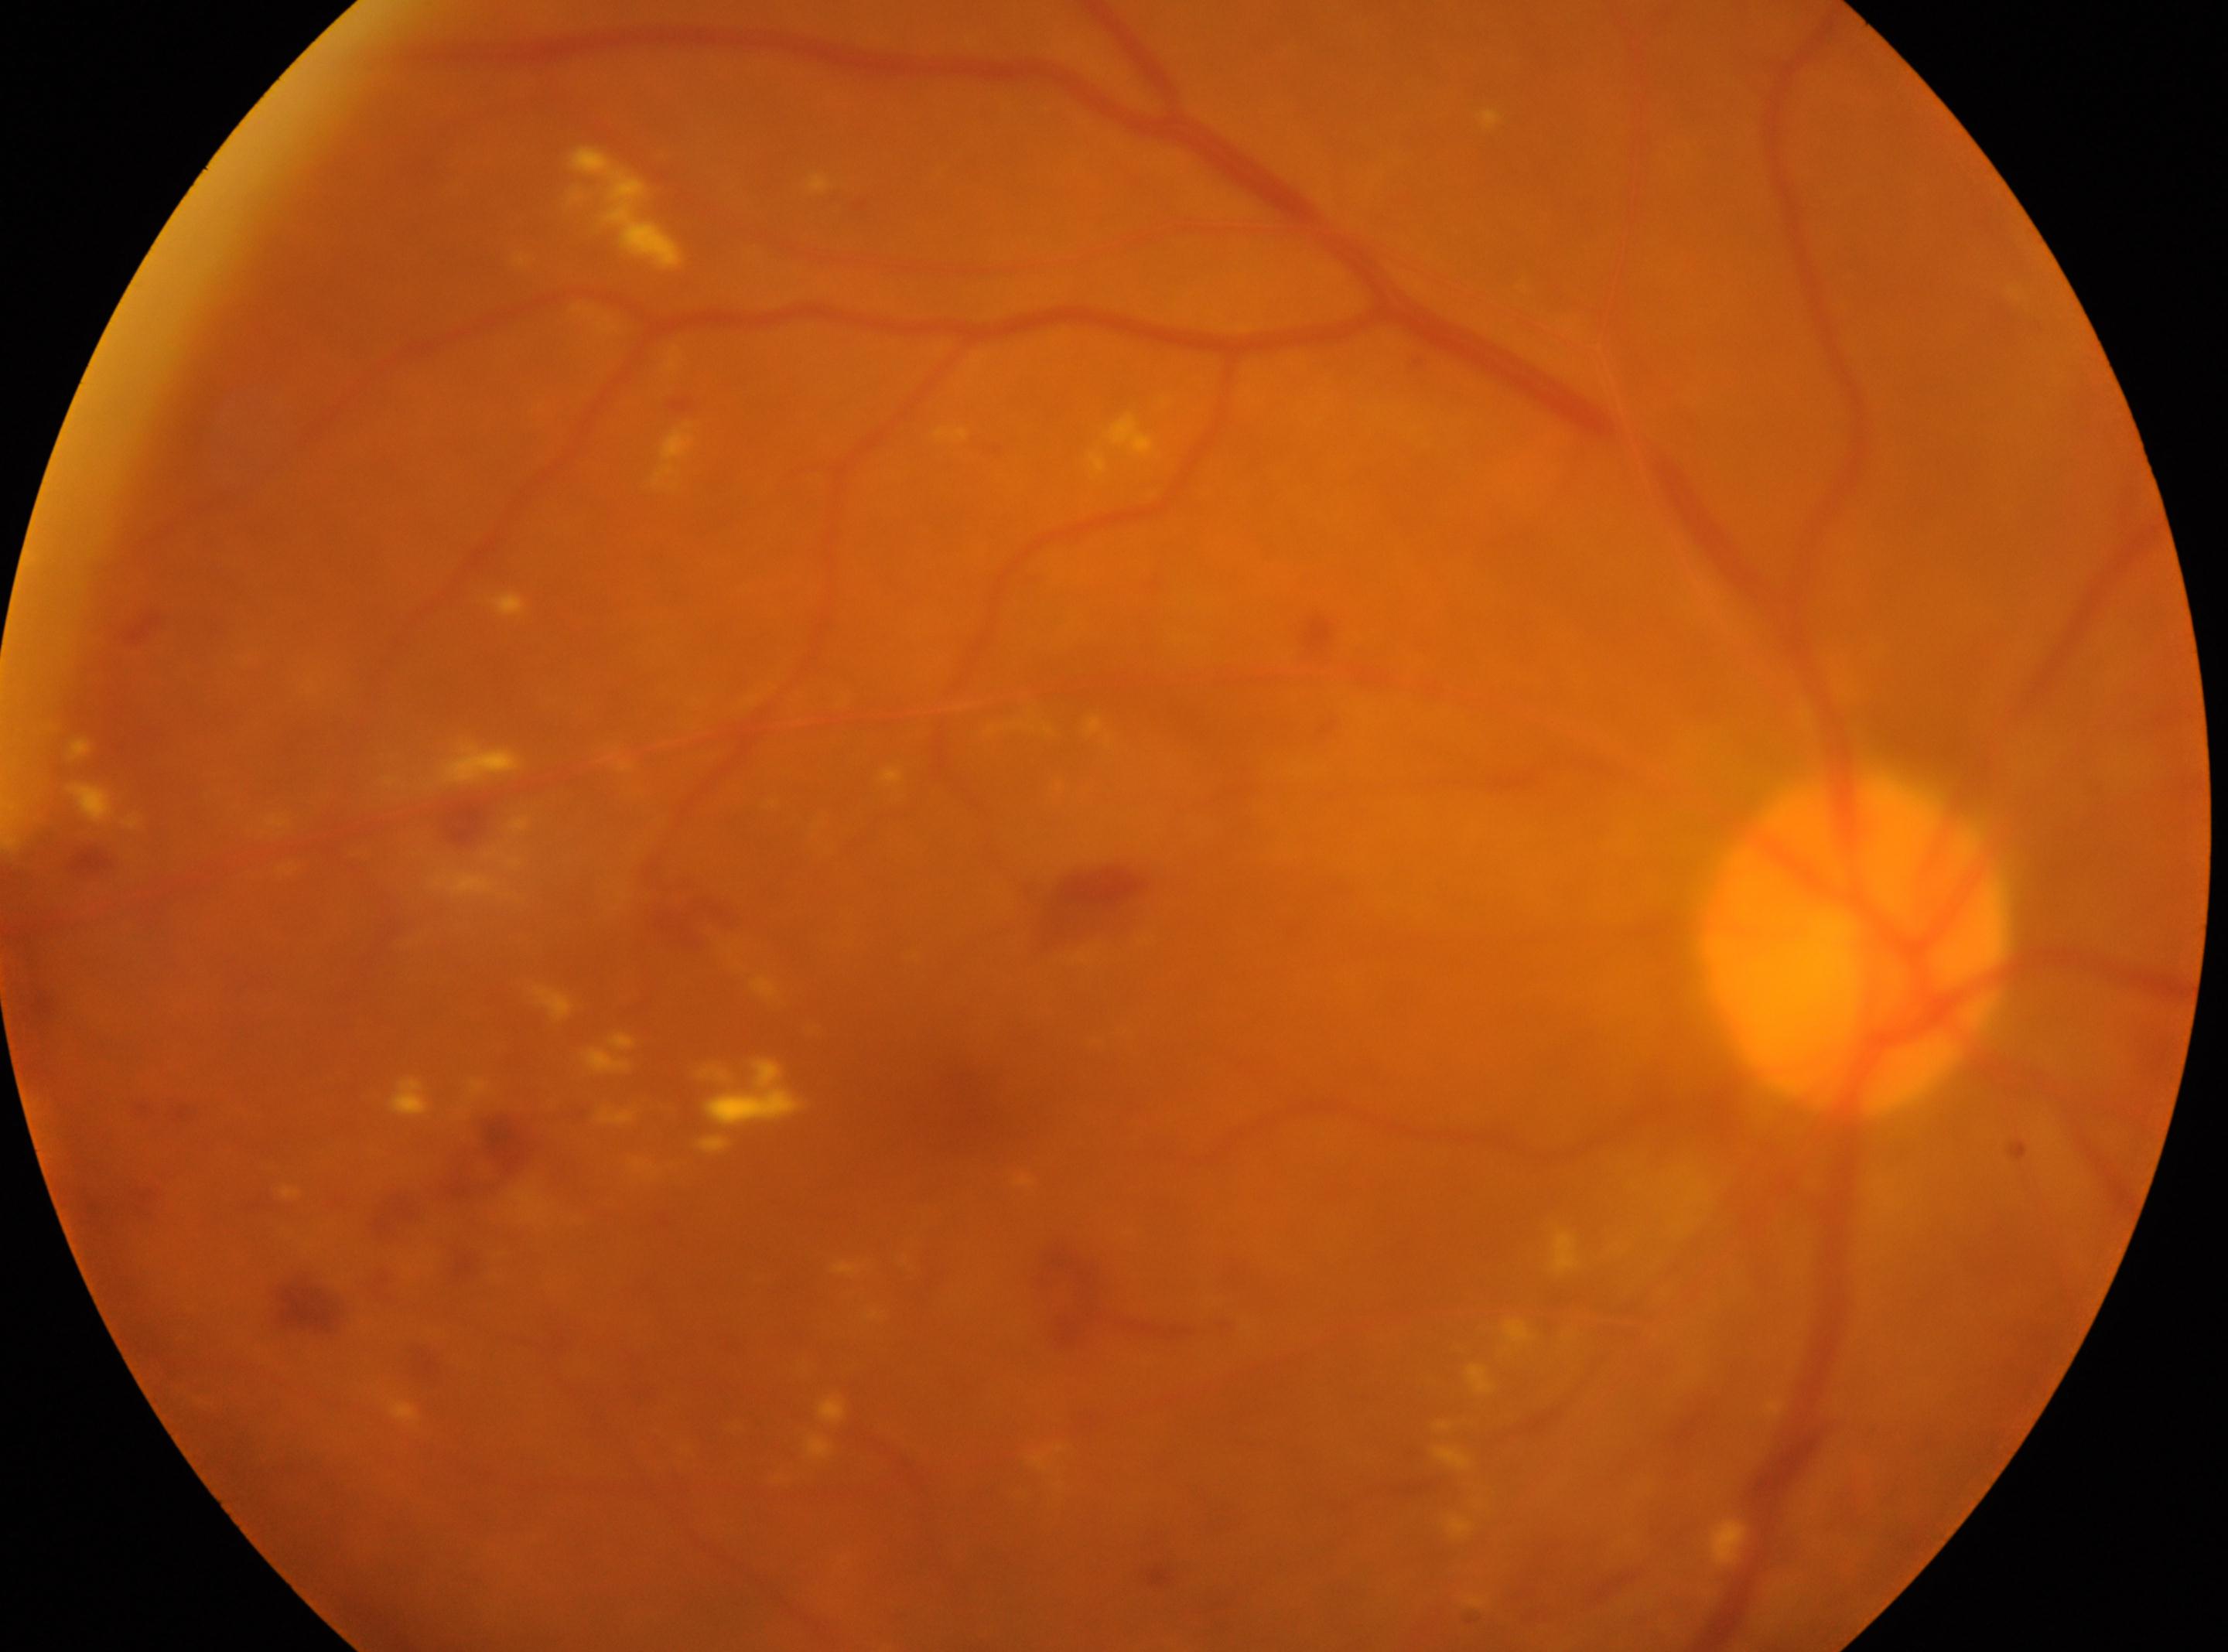 macular center = 965px, 1100px
DR stage = moderate non-proliferative diabetic retinopathy (grade 2)
laterality = the right eye
disc center = 1854px, 944px